Graded on the modified Davis scale. NIDEK AFC-230: 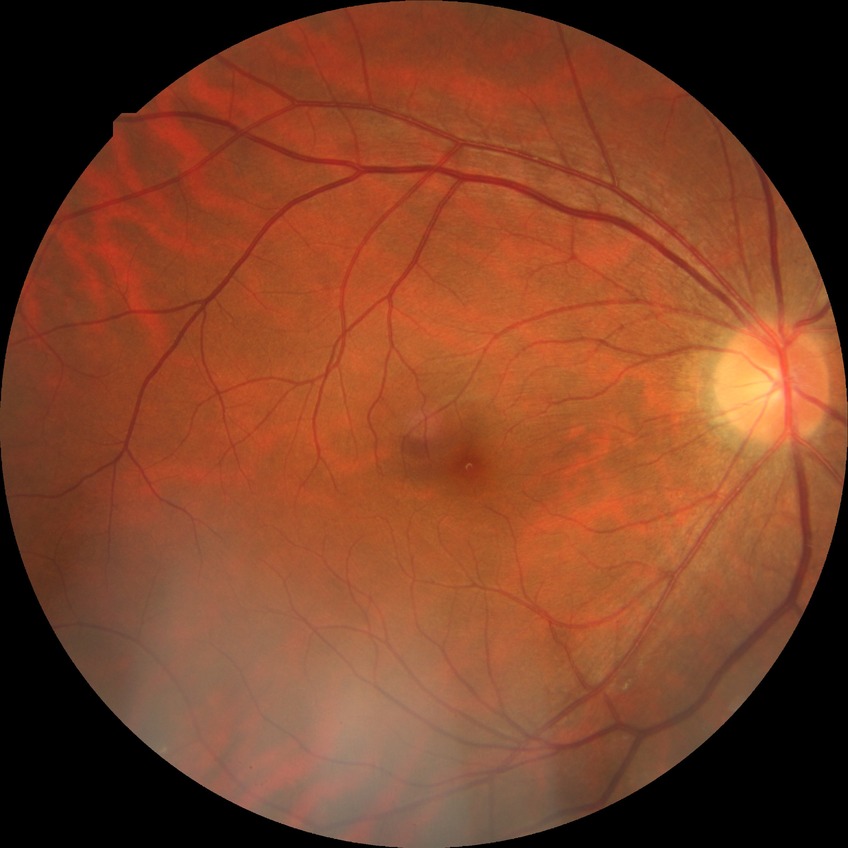 No DR findings. DR severity: NDR.